Pediatric retinal photograph (wide-field):
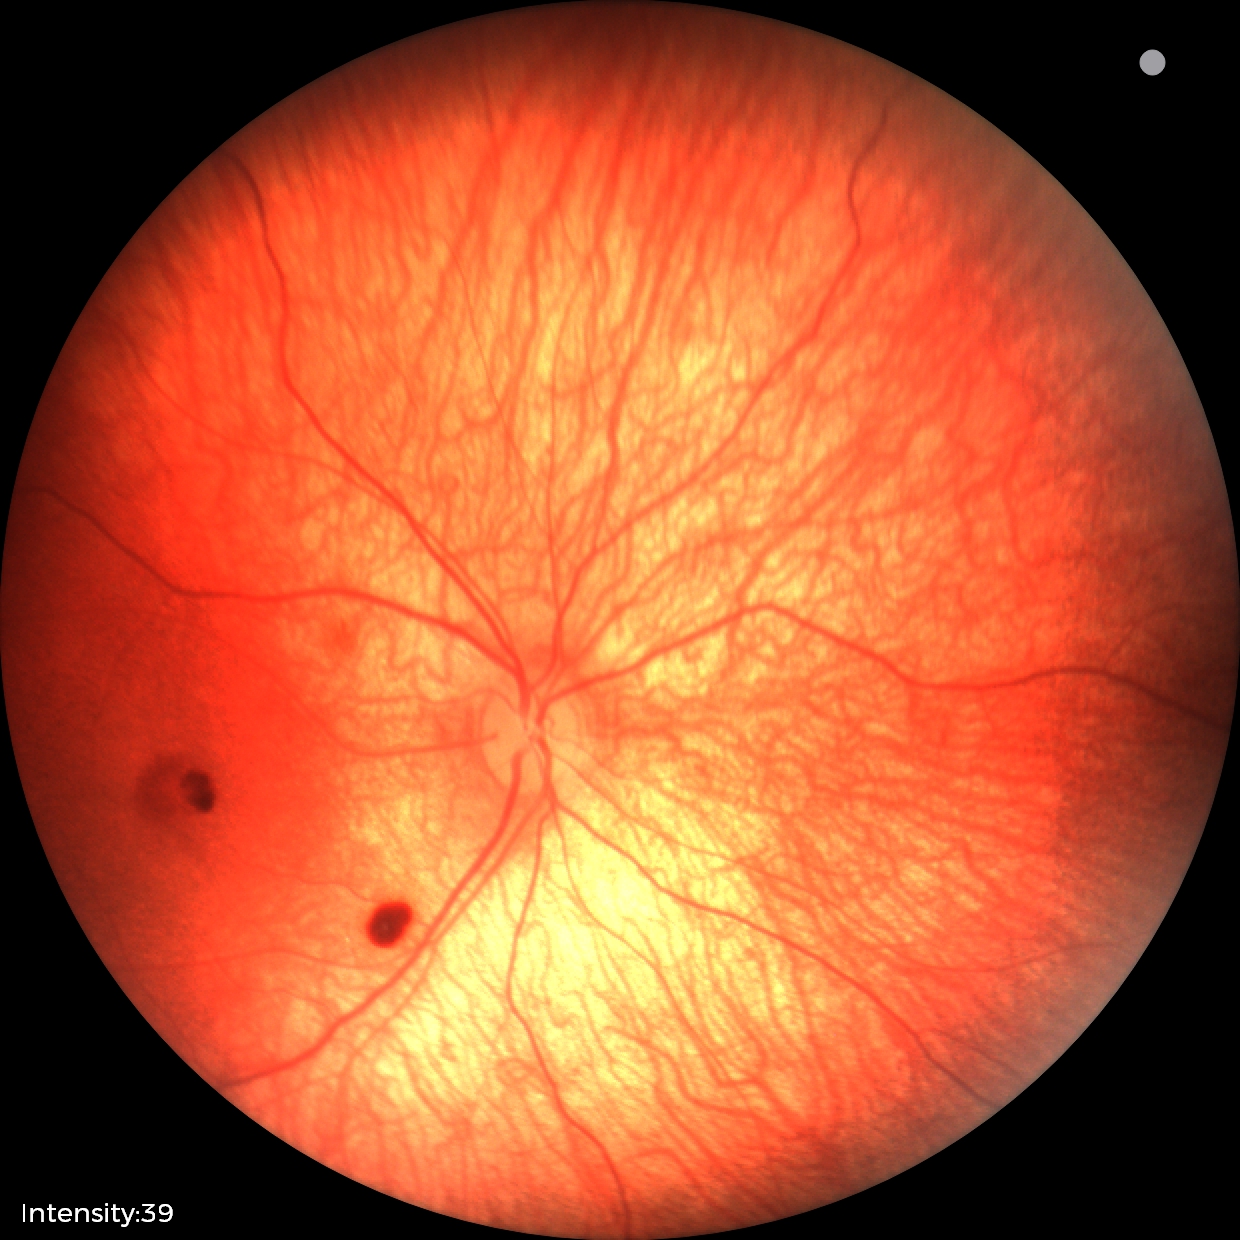
Screening series with retinal hemorrhages.